Acquired with a Remidio smartphone fundus camera.
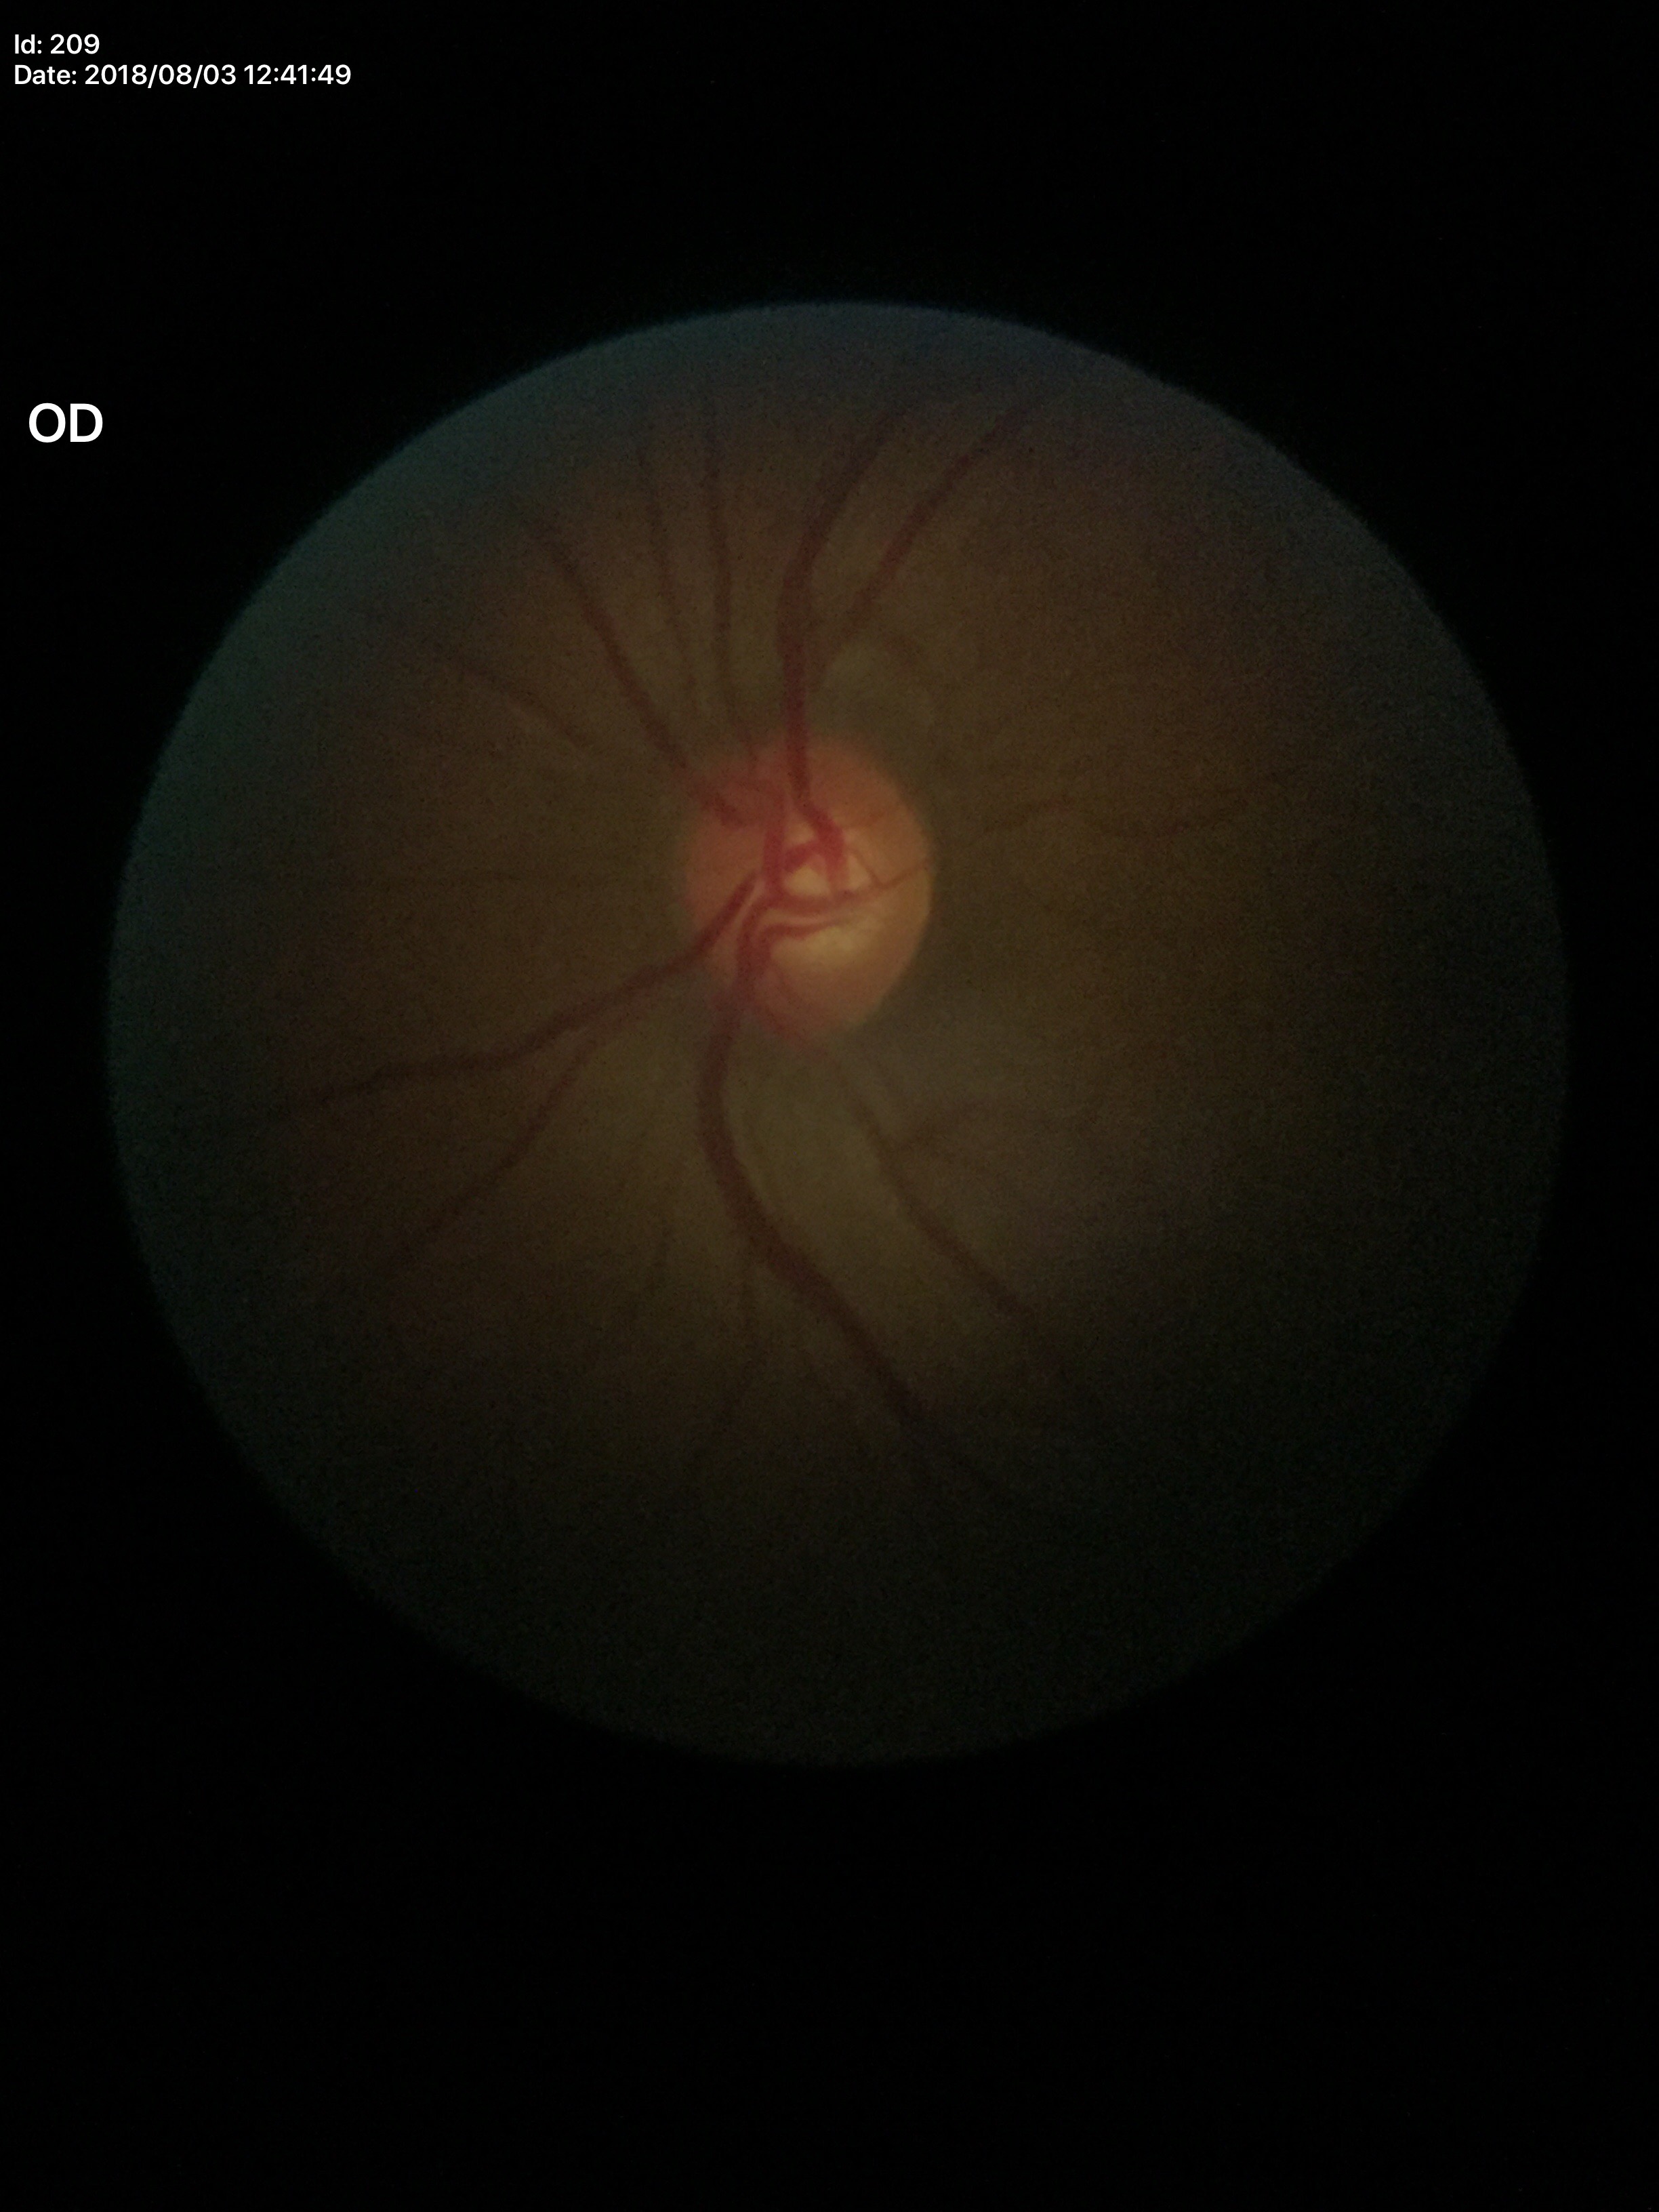 Optic disc analysis:
* Glaucoma screening · no suspicious findings
* vertical C/D ratio (VCDR) · 0.51